Color fundus image: 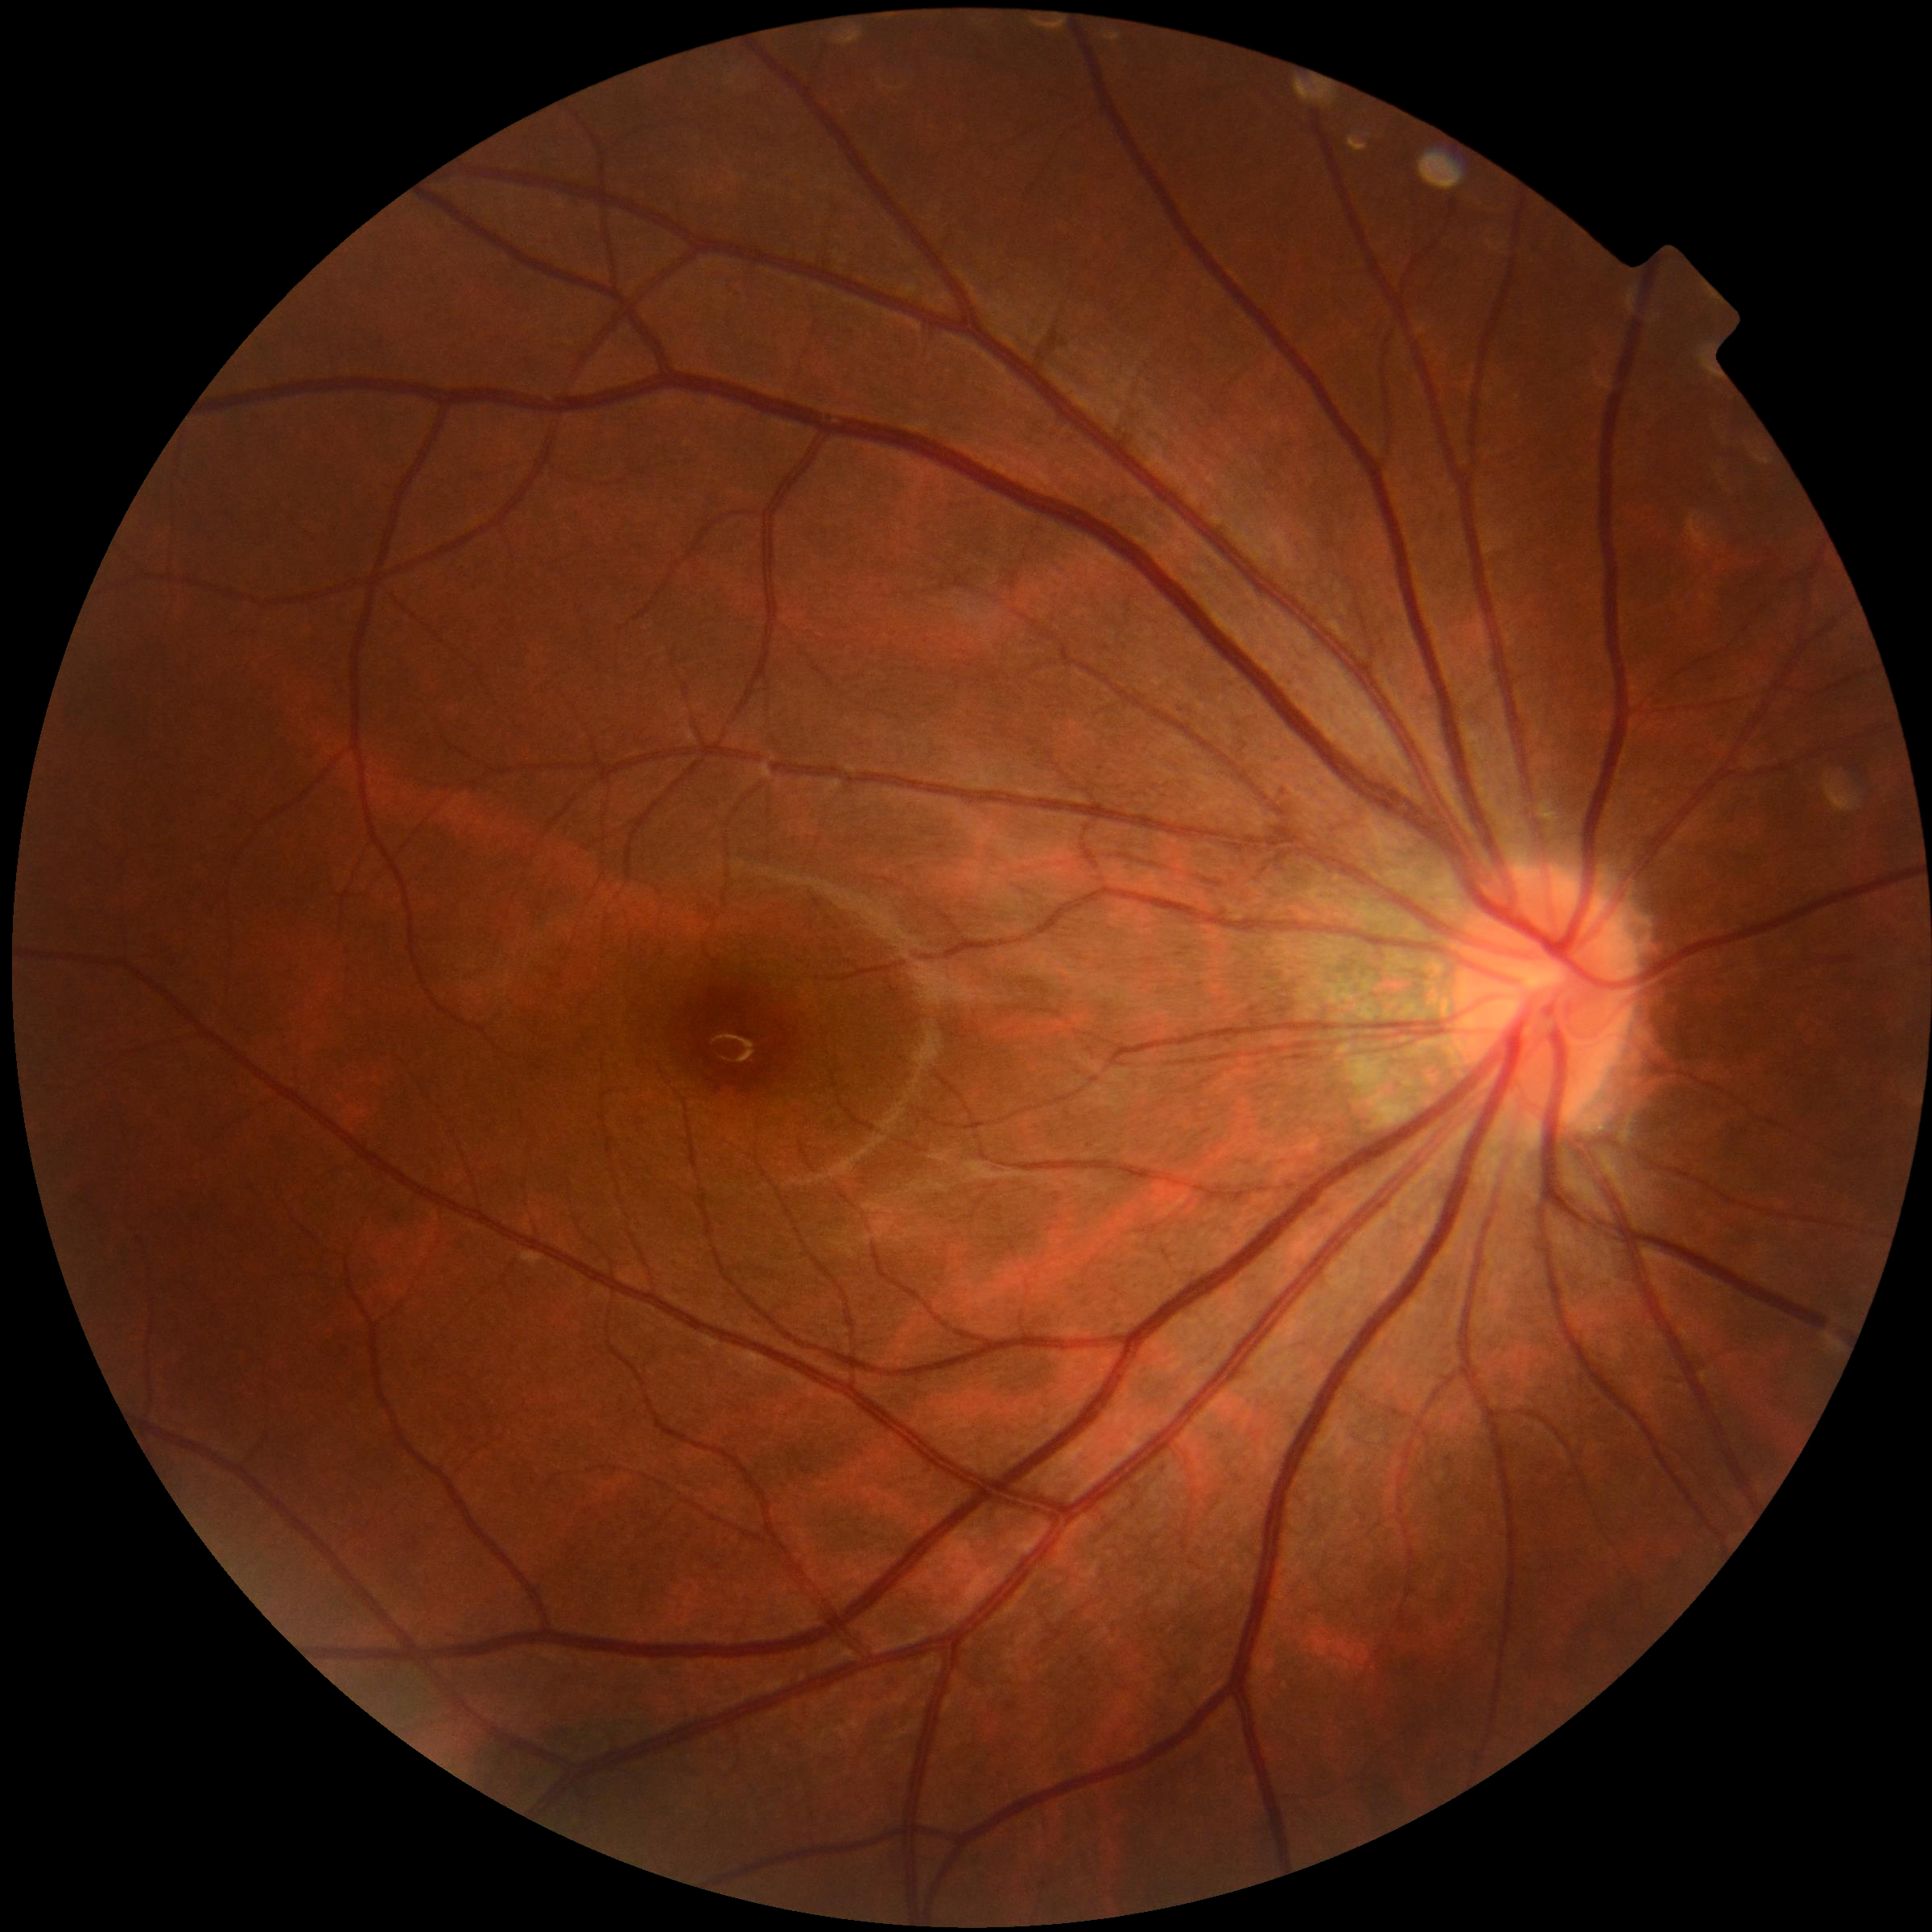
DR: no apparent diabetic retinopathy (grade 0).